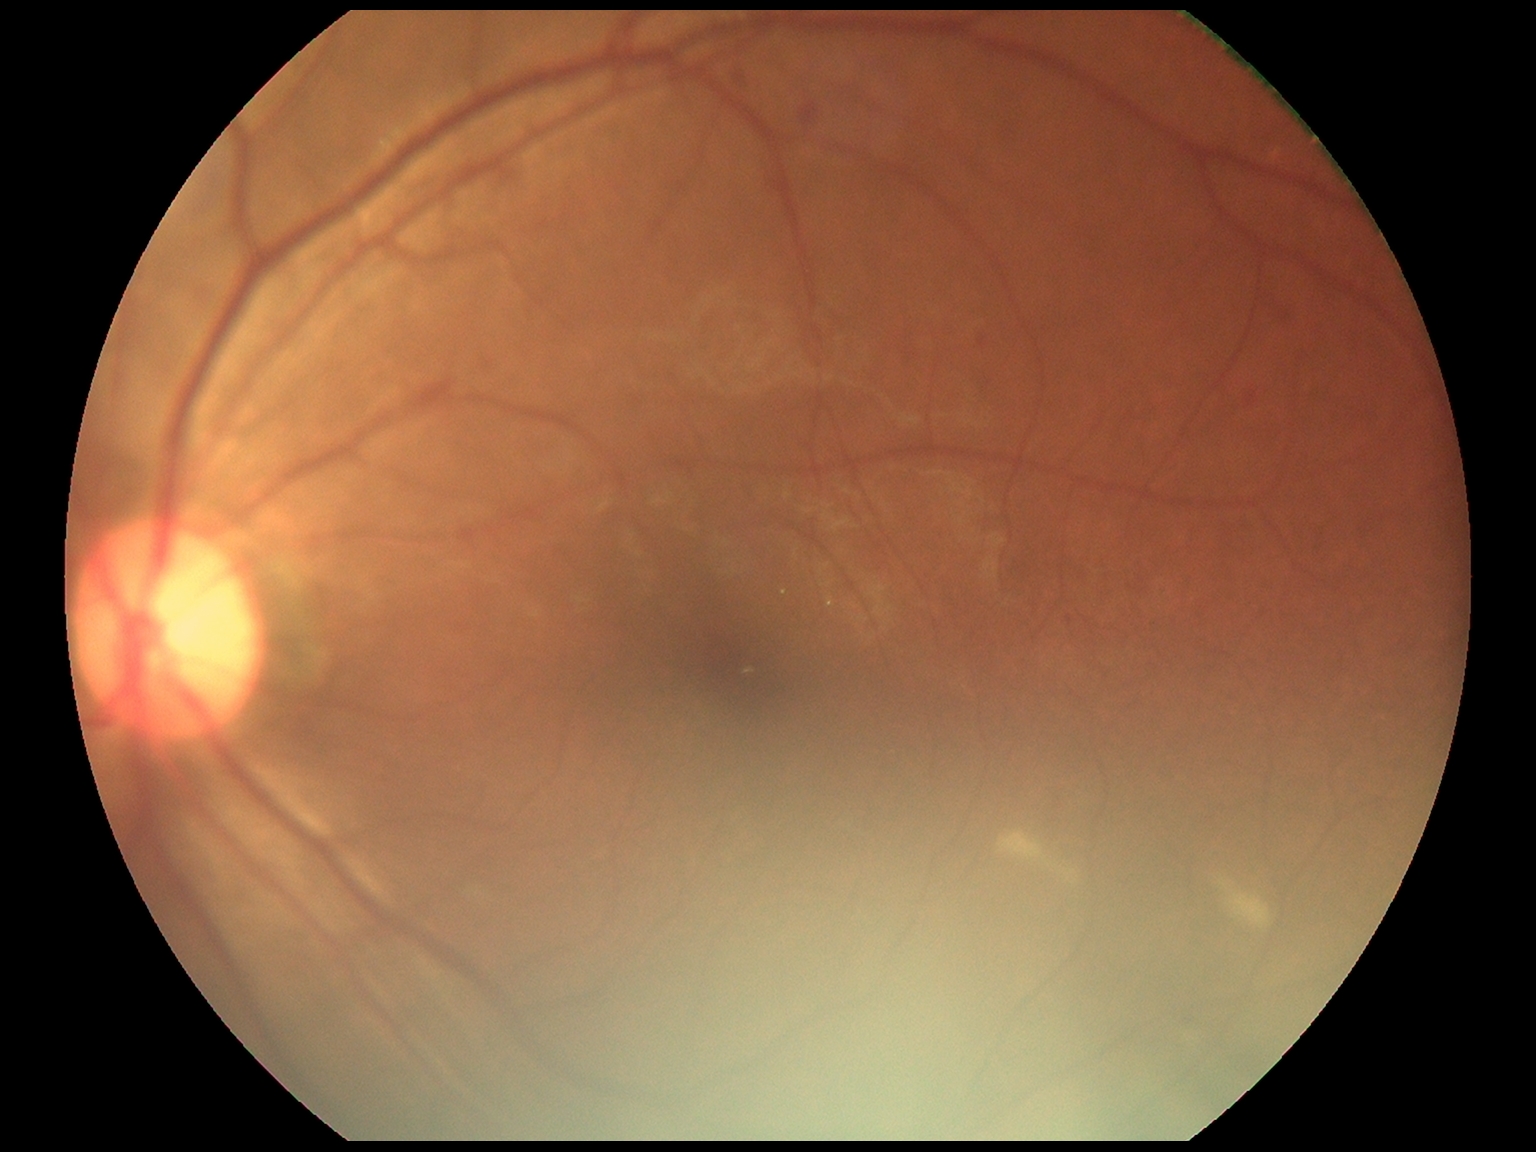 DR is grade 2 — more than just microaneurysms but less than severe NPDR. DR class: non-proliferative diabetic retinopathy.